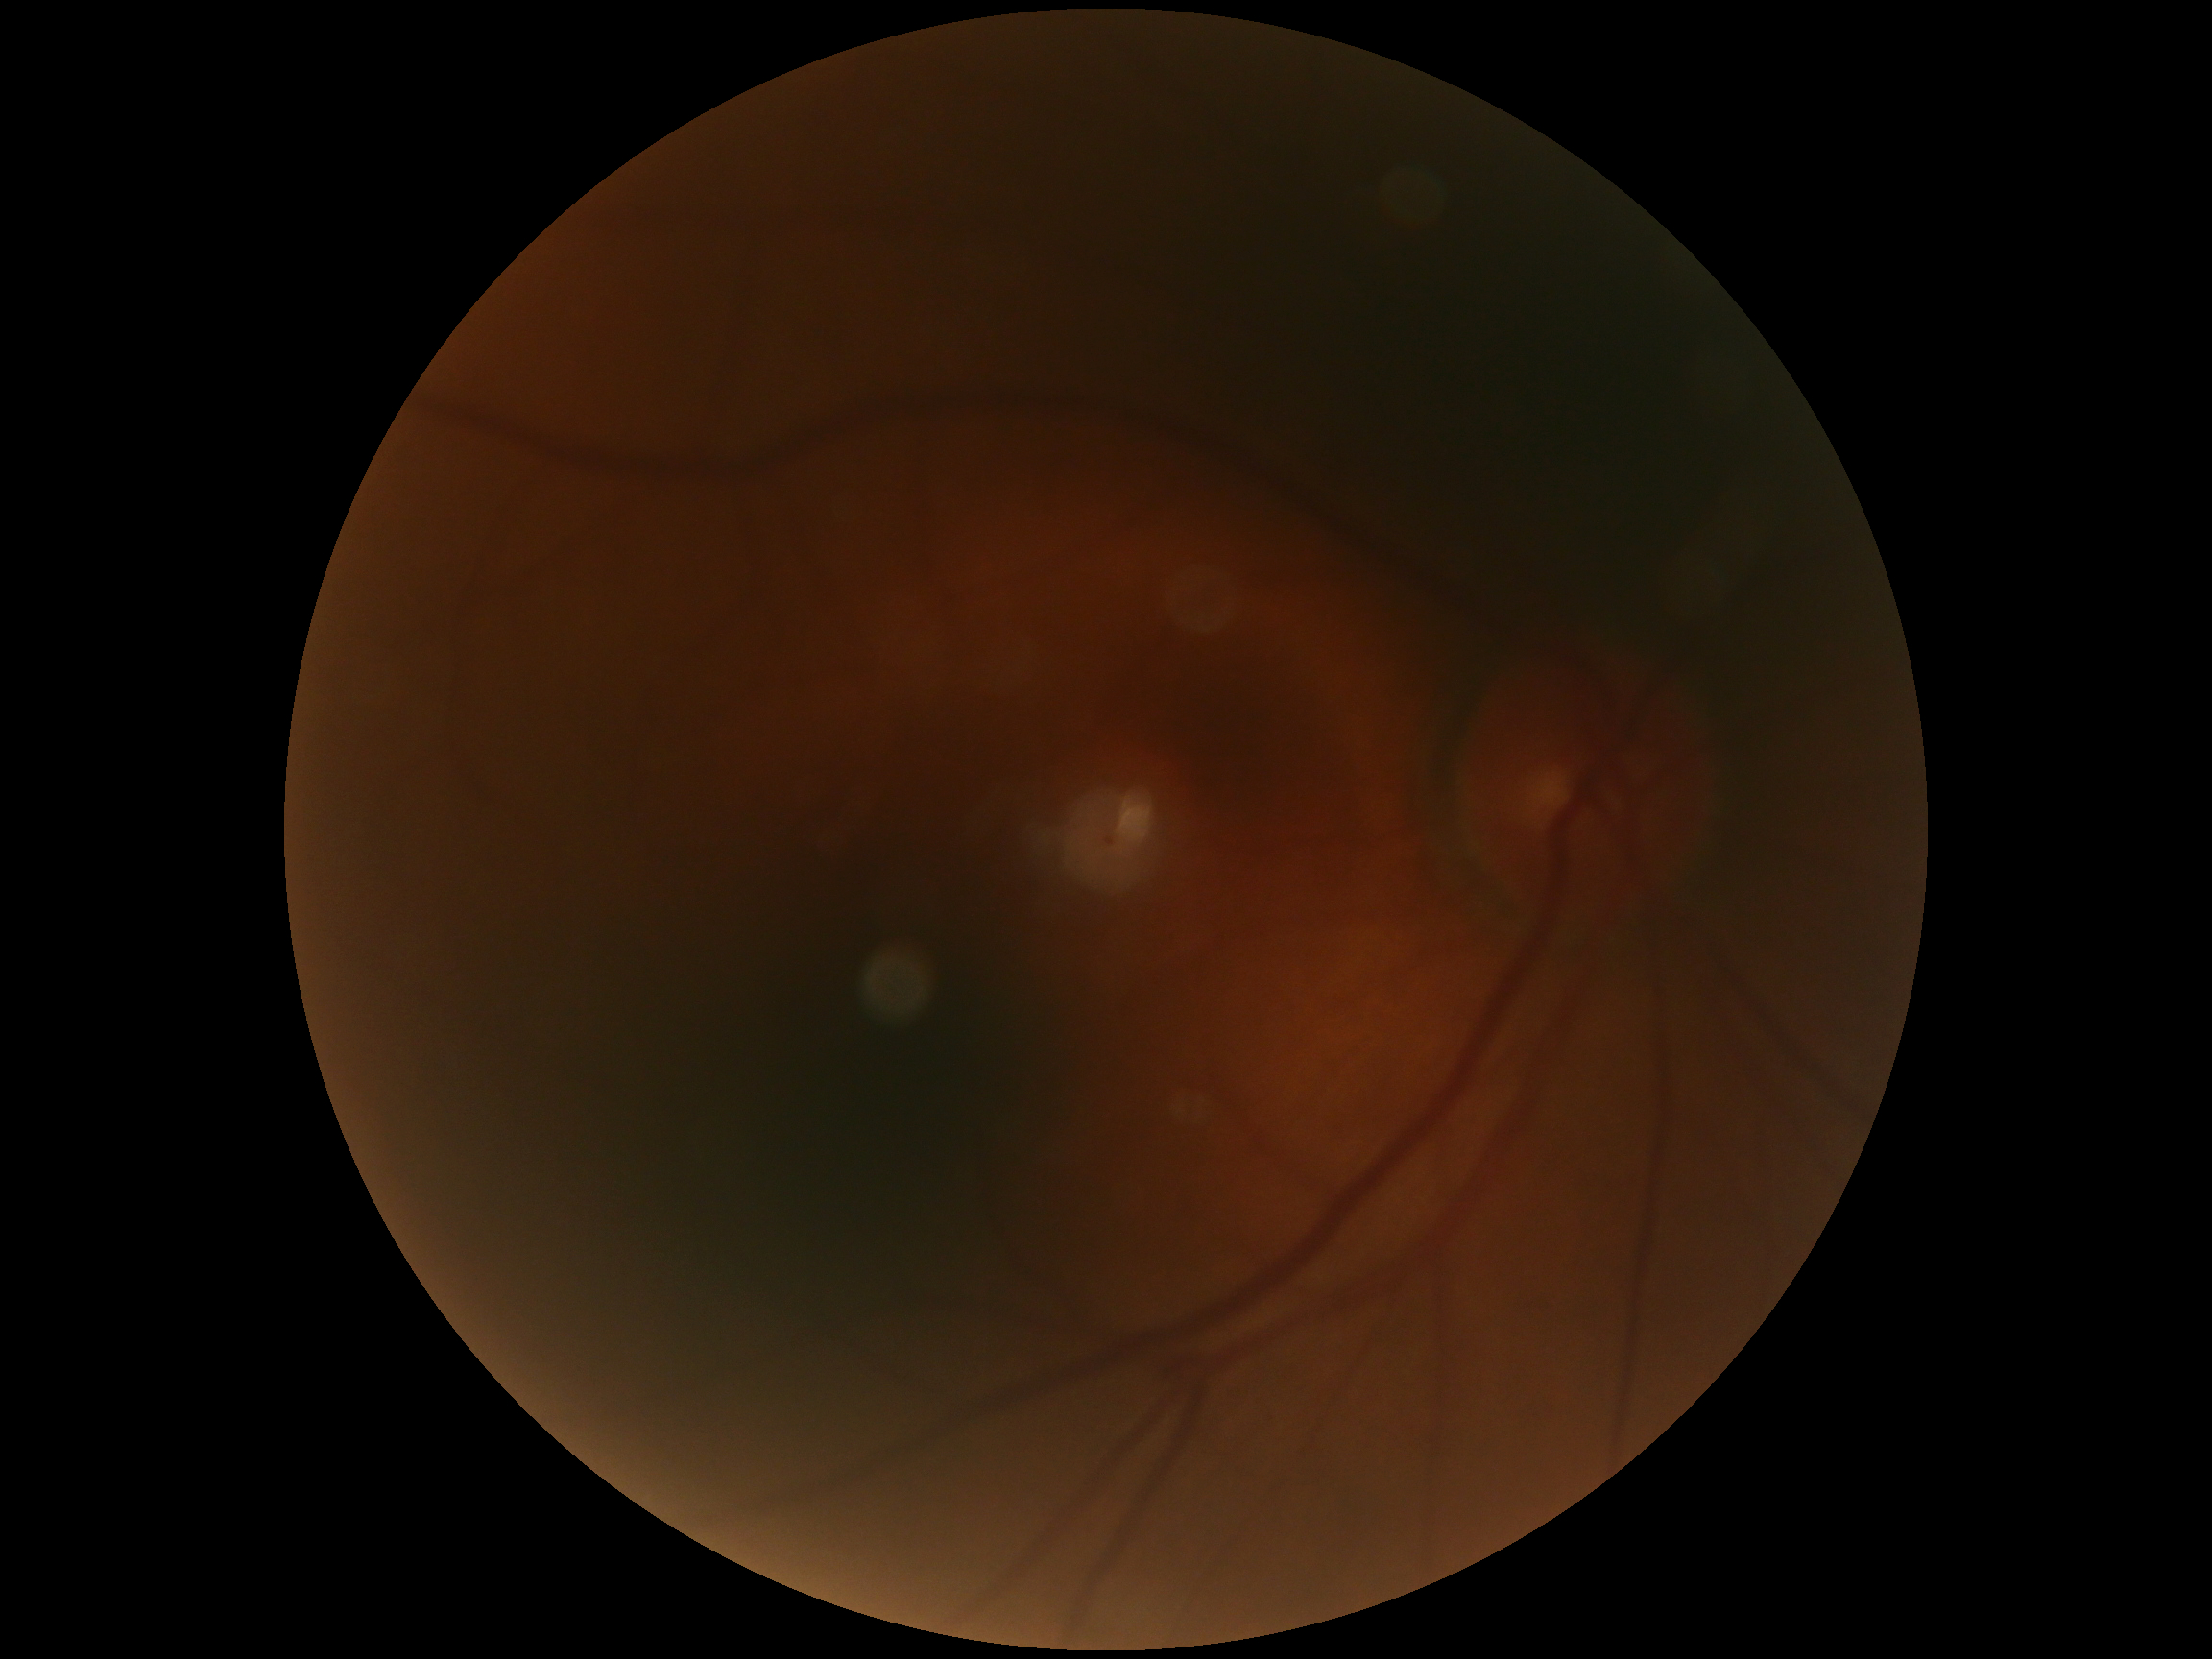

No DR findings.
Diabetic retinopathy severity is grade 0 (no apparent retinopathy) — no visible signs of diabetic retinopathy.